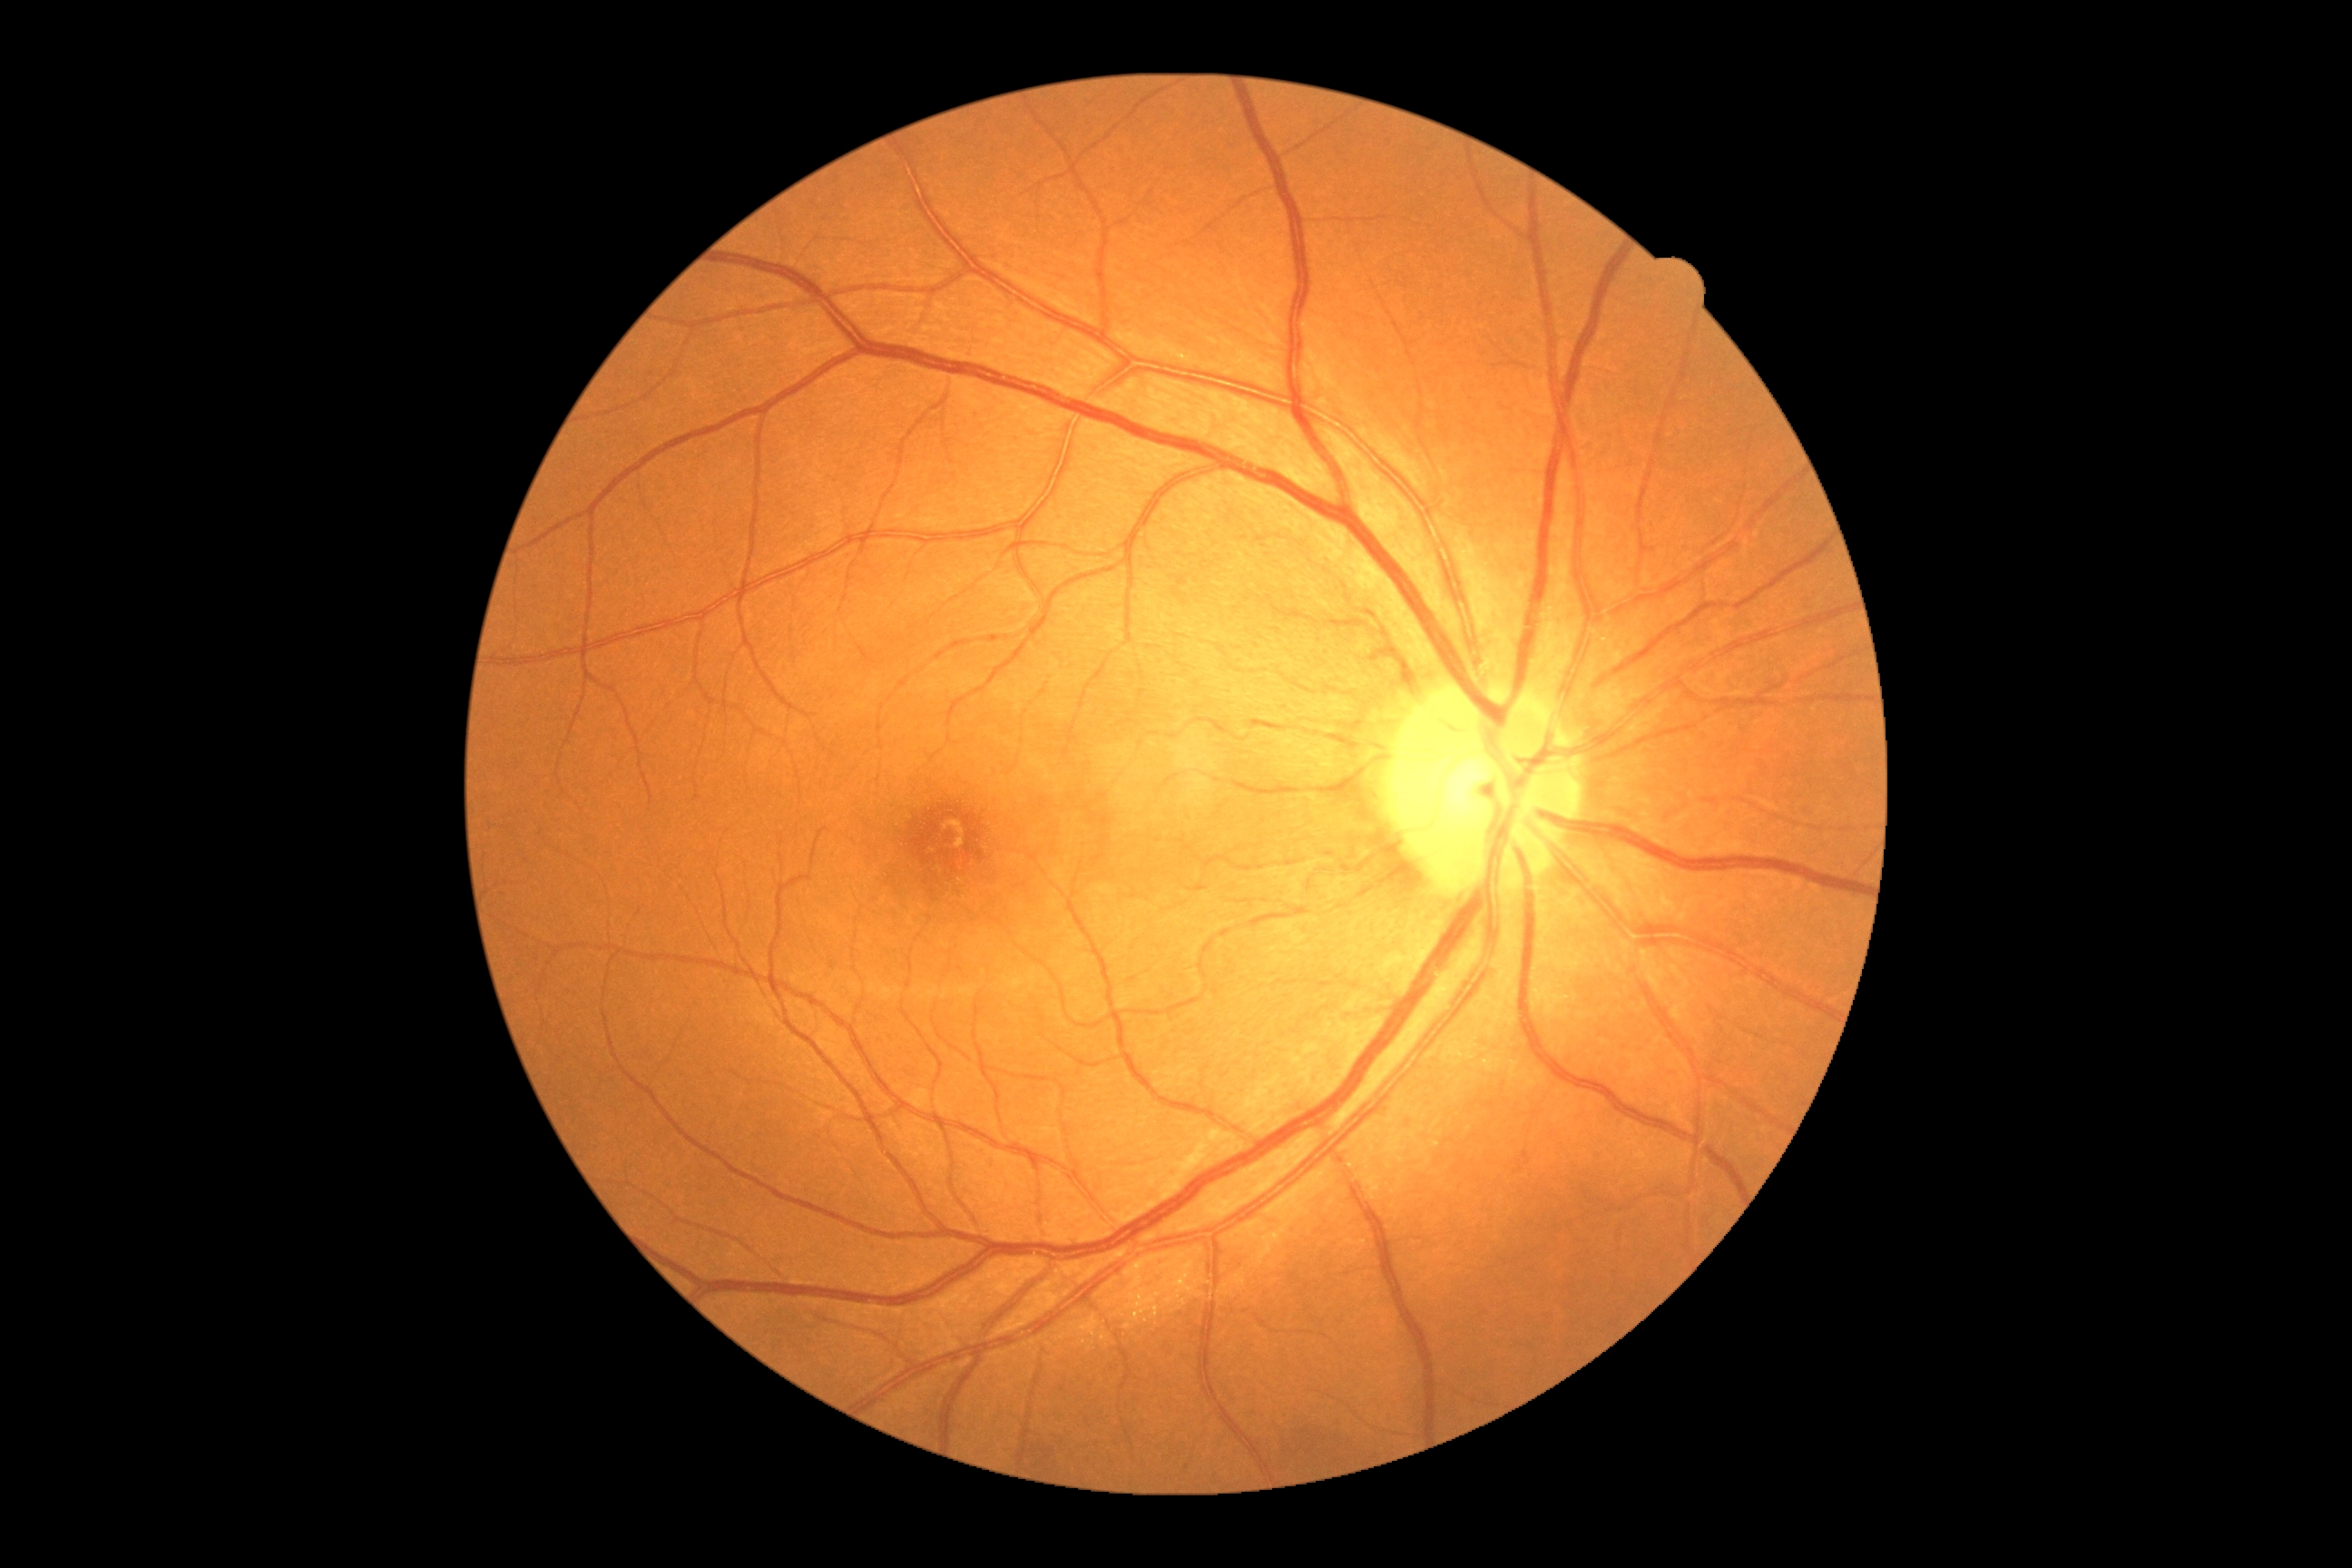 DR: grade 0.